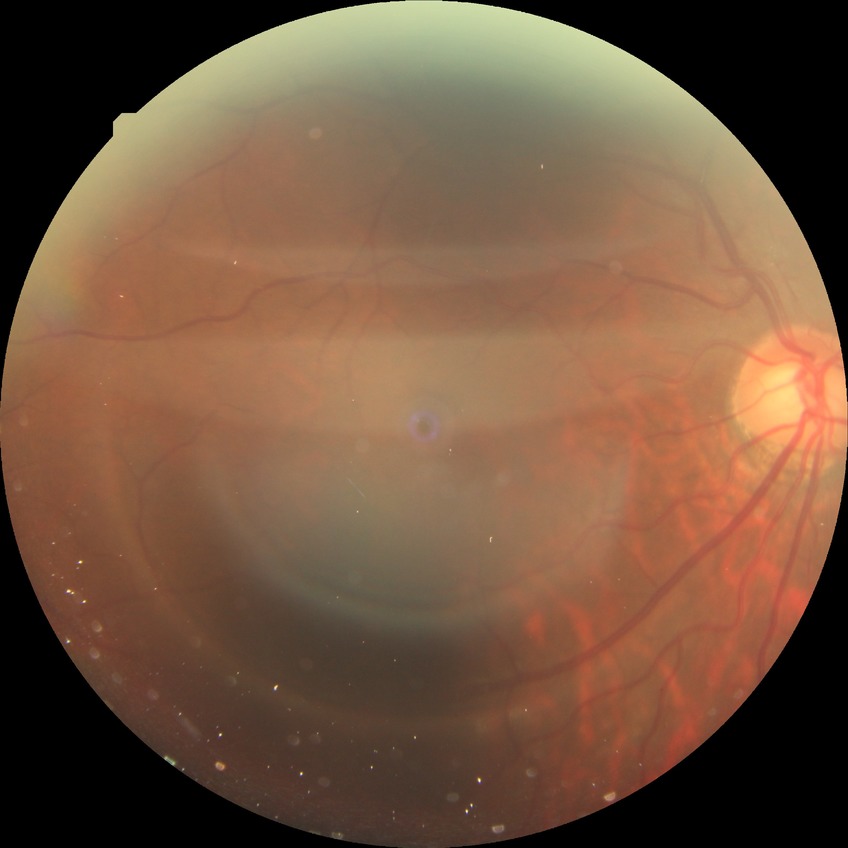 diabetic retinopathy (DR): NDR (no diabetic retinopathy)